Acquired on the Phoenix ICON. Wide-field fundus image from infant ROP screening. 1240 by 1240 pixels:
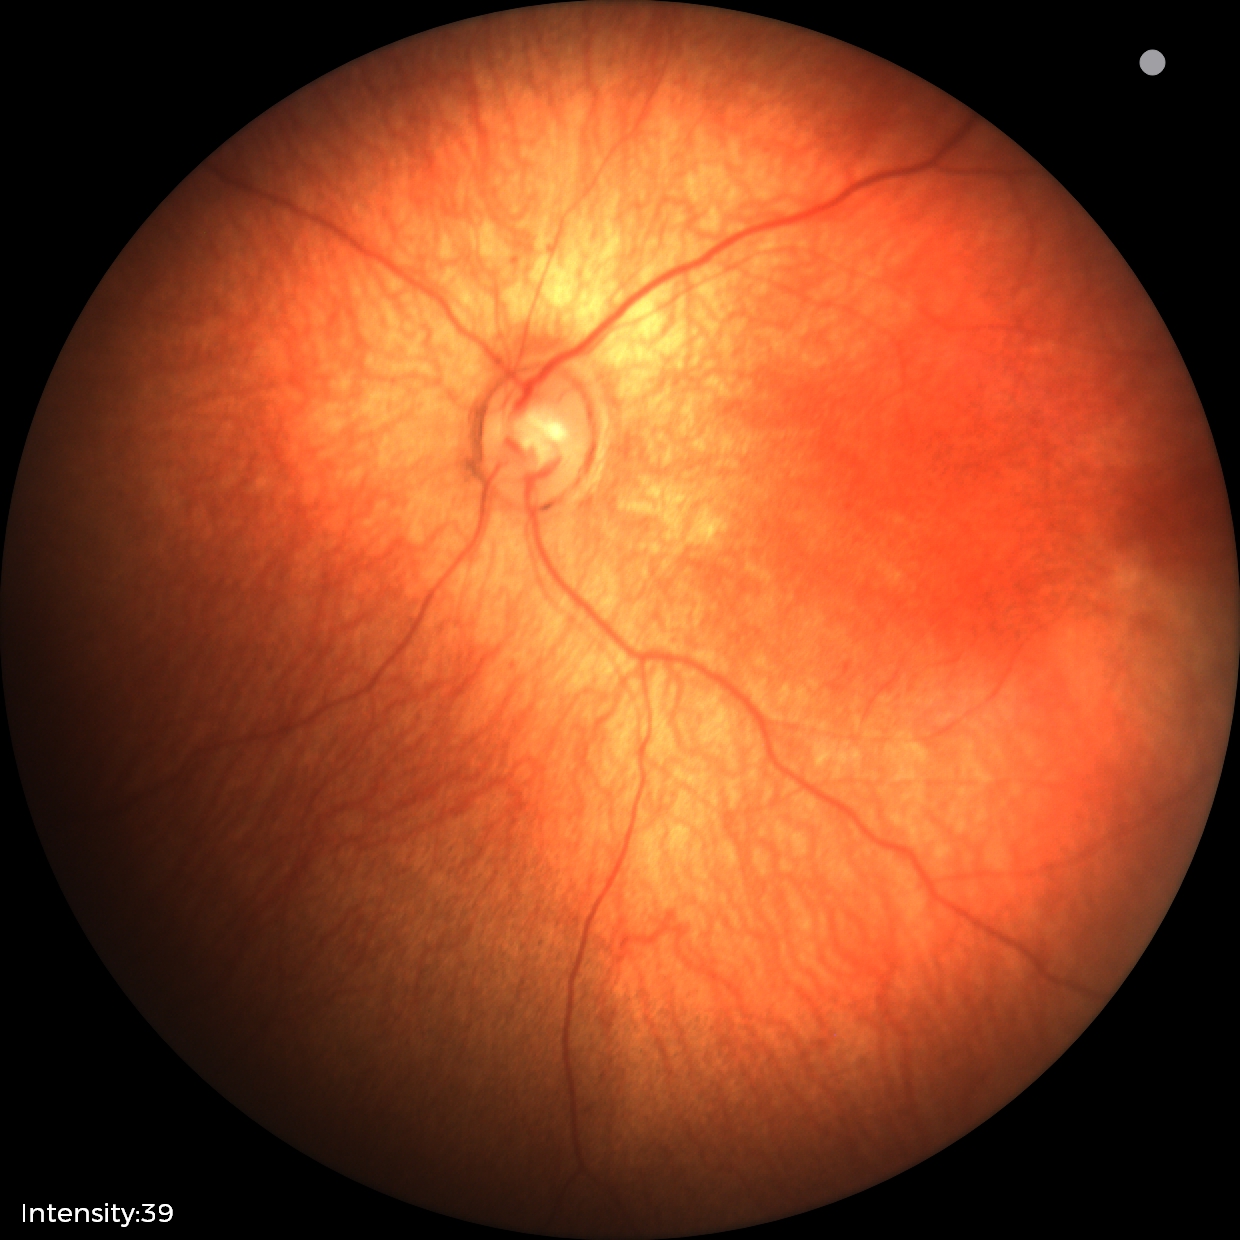 Impression: no abnormalities.